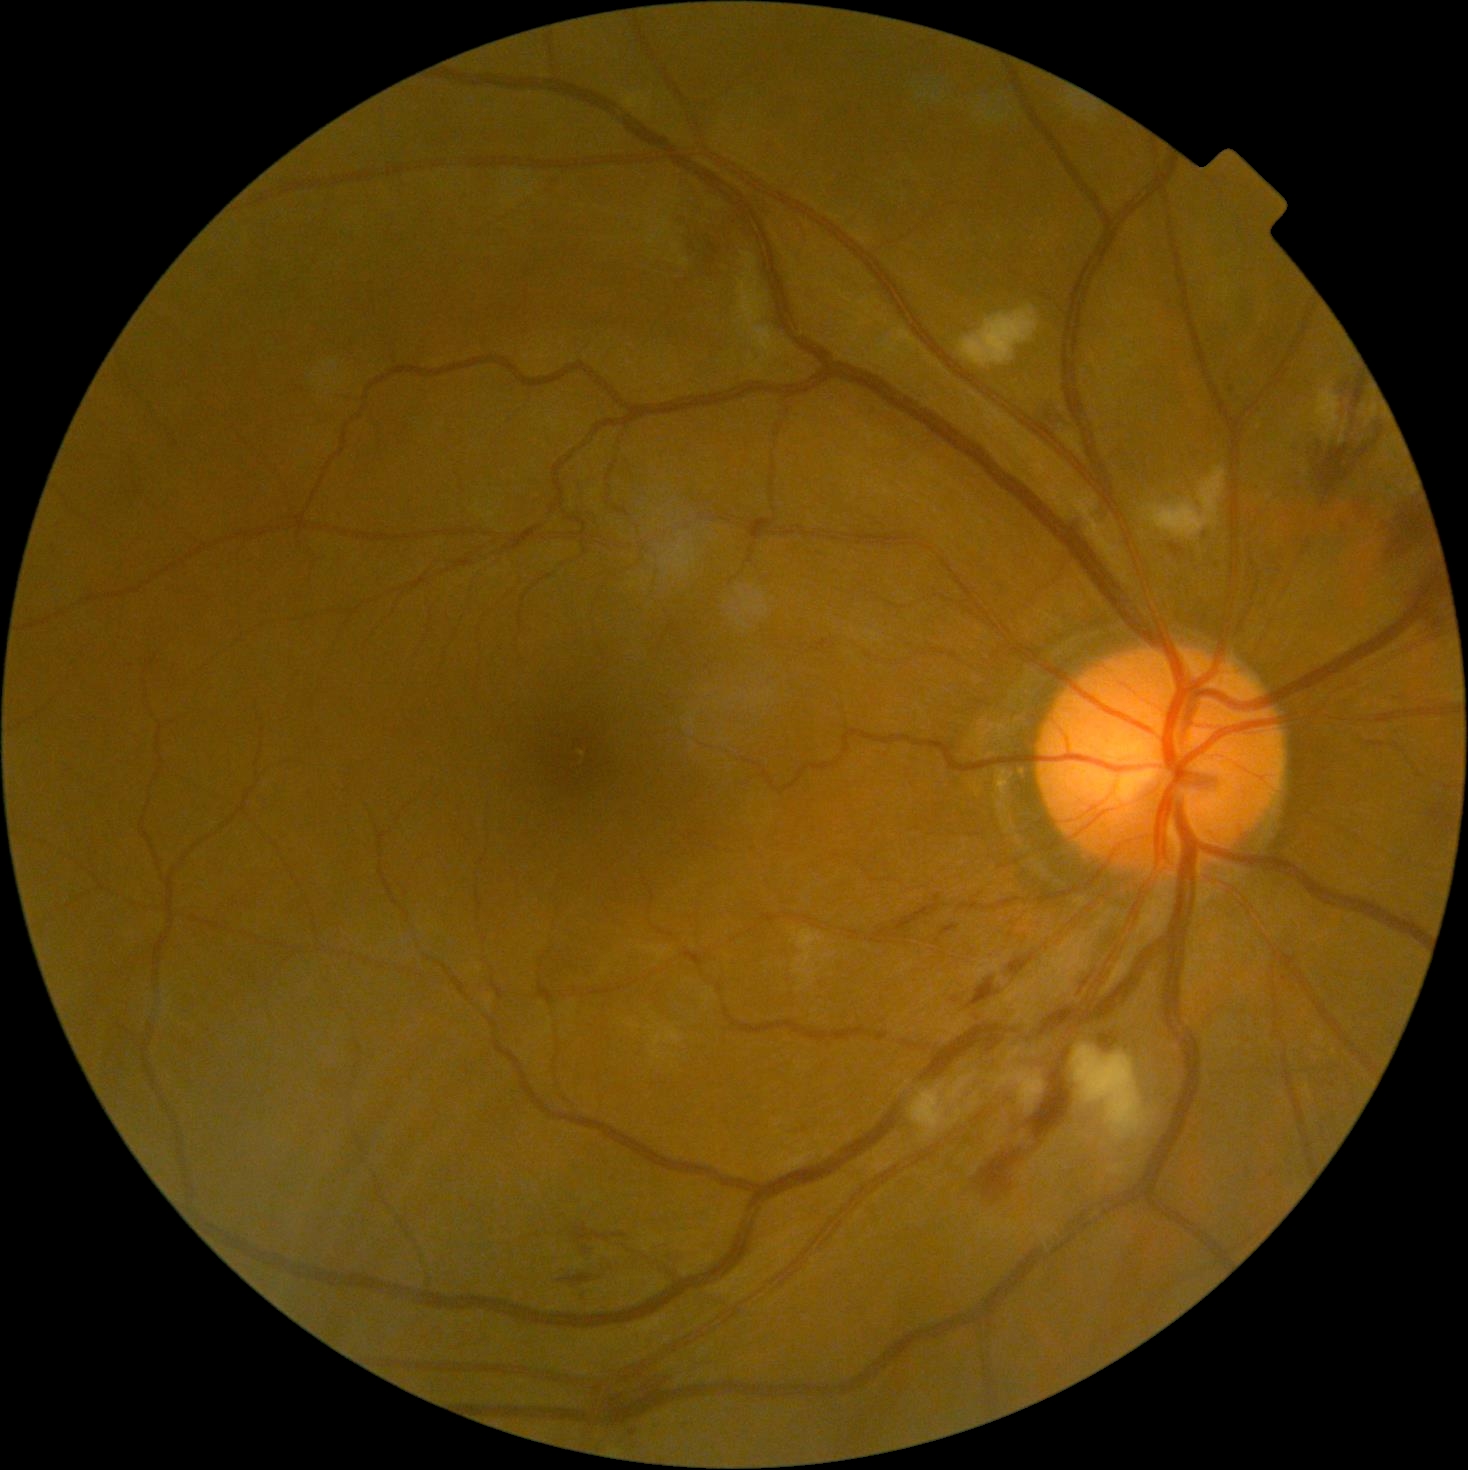

diabetic retinopathy (DR): moderate non-proliferative diabetic retinopathy (grade 2) — more than just microaneurysms but less than severe NPDR | DR class: non-proliferative diabetic retinopathy.